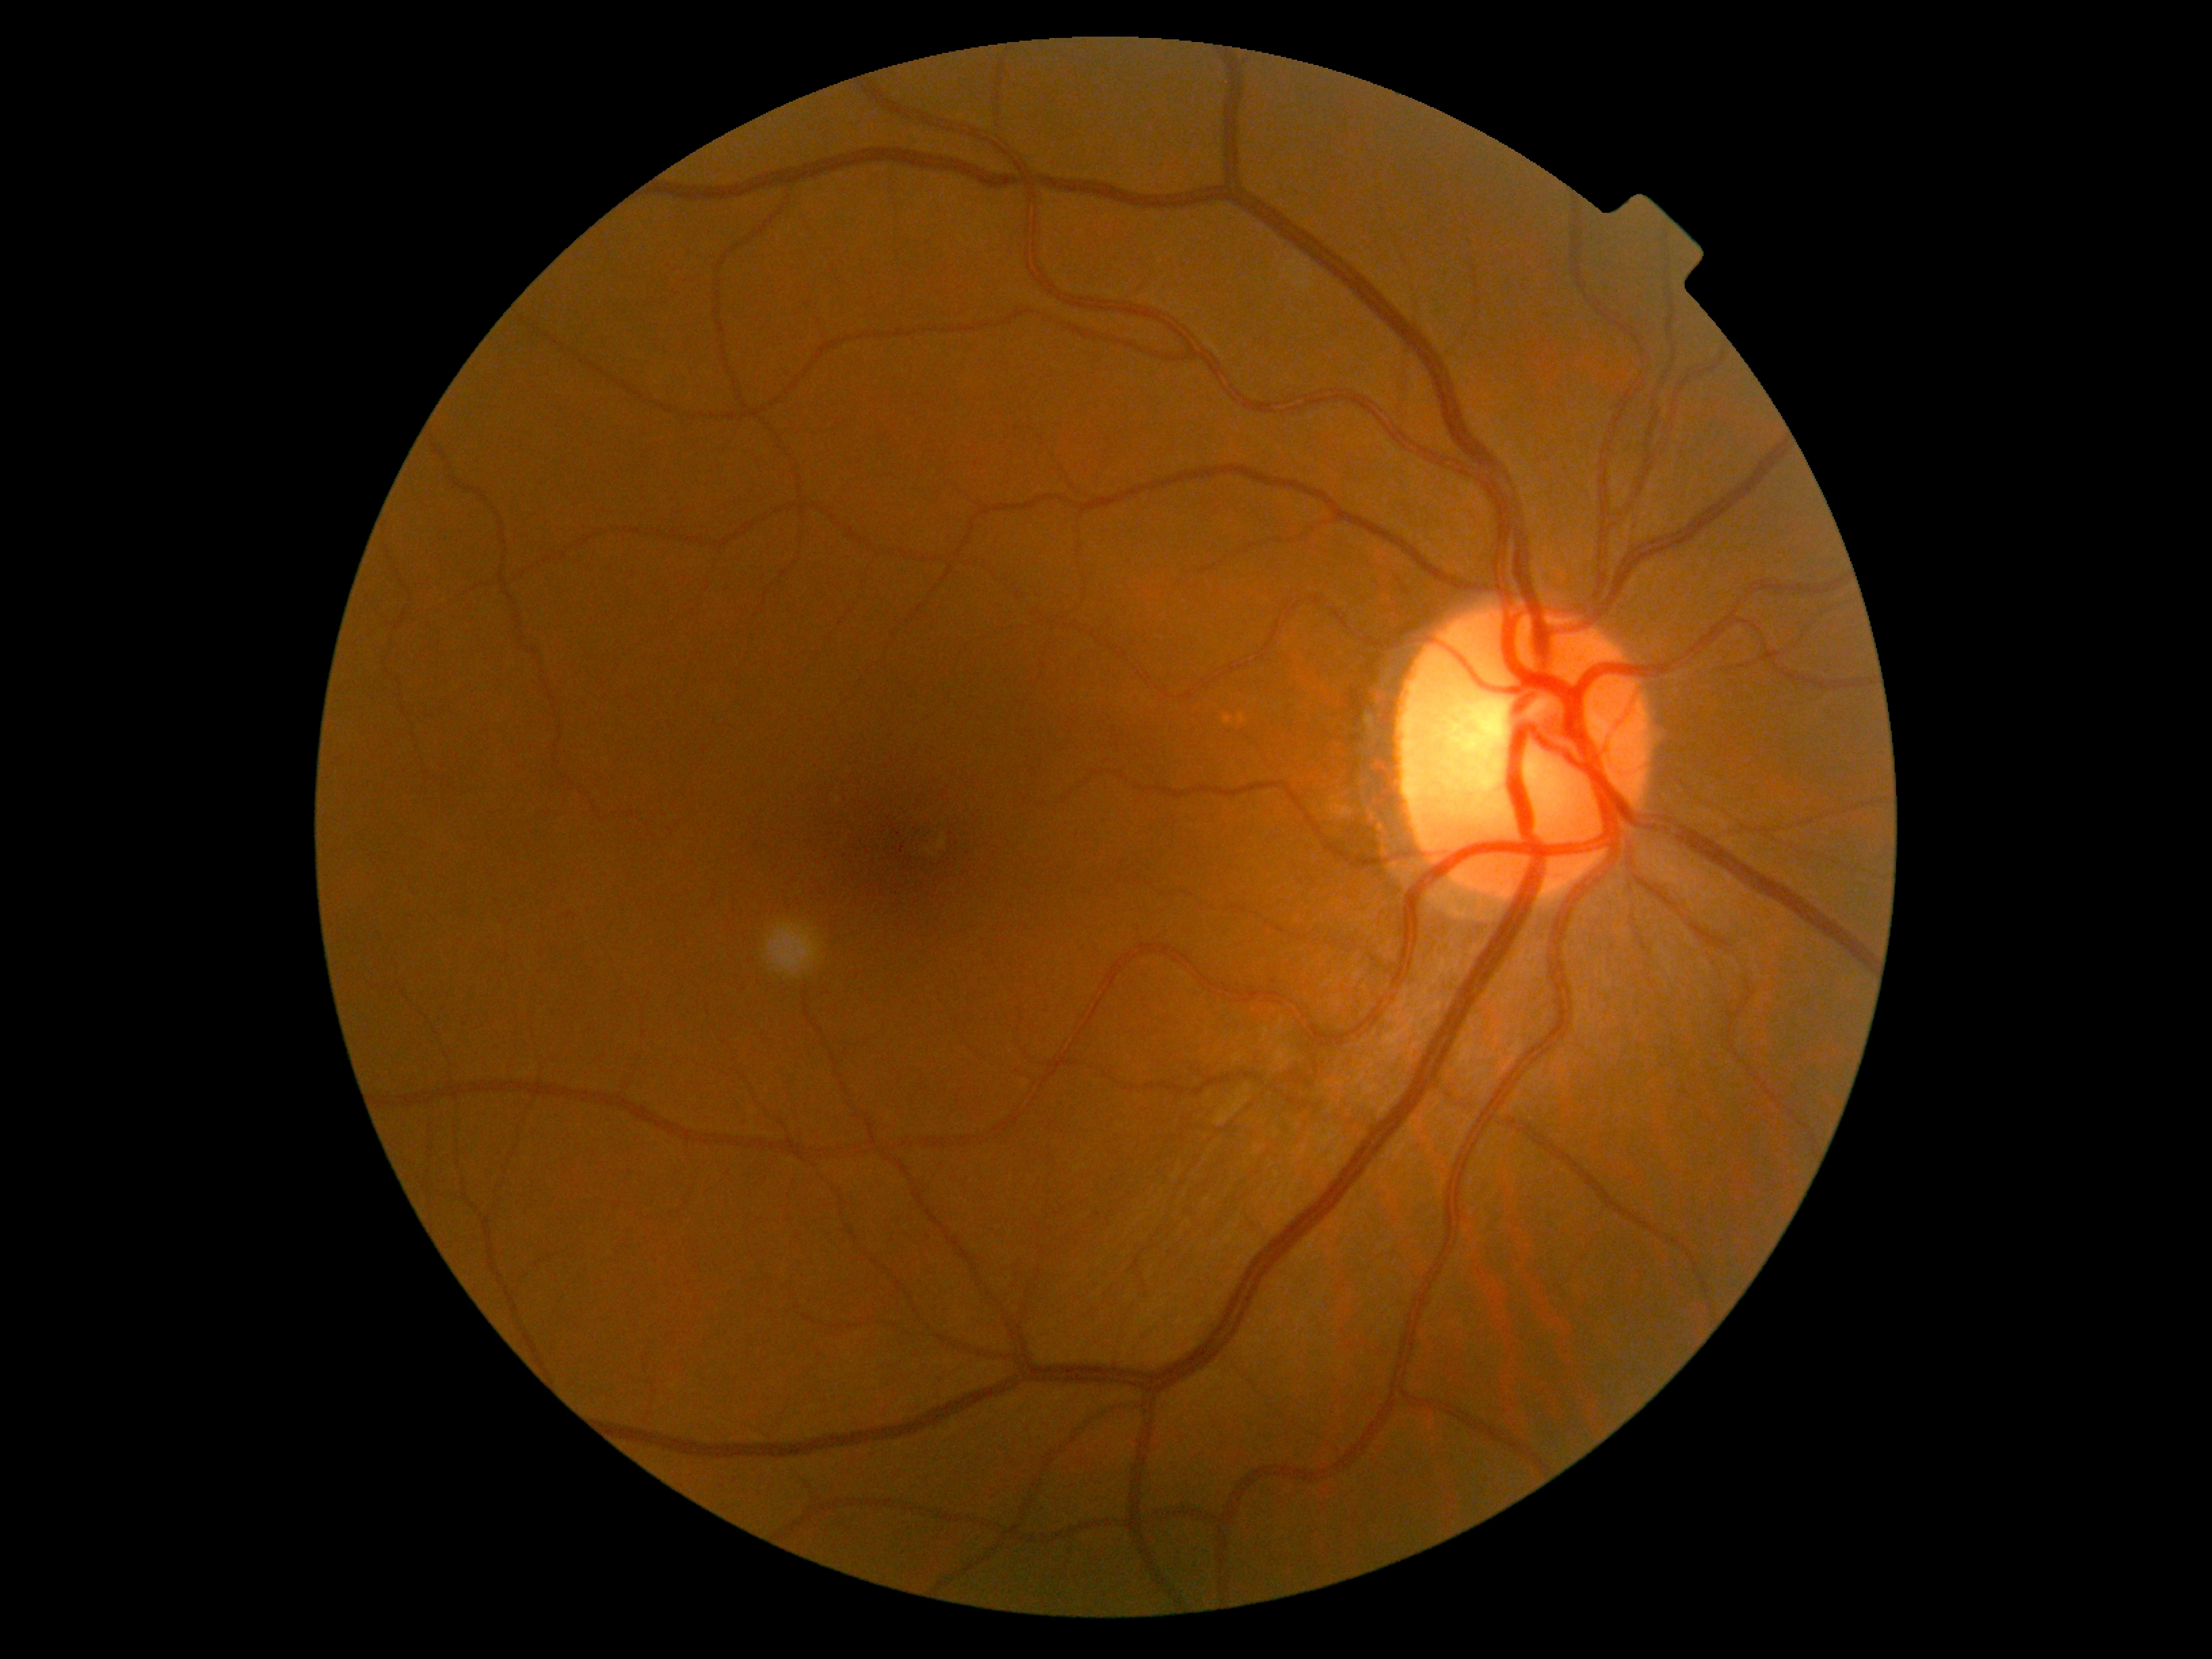
DR severity is no apparent retinopathy (grade 0) — no visible signs of diabetic retinopathy.